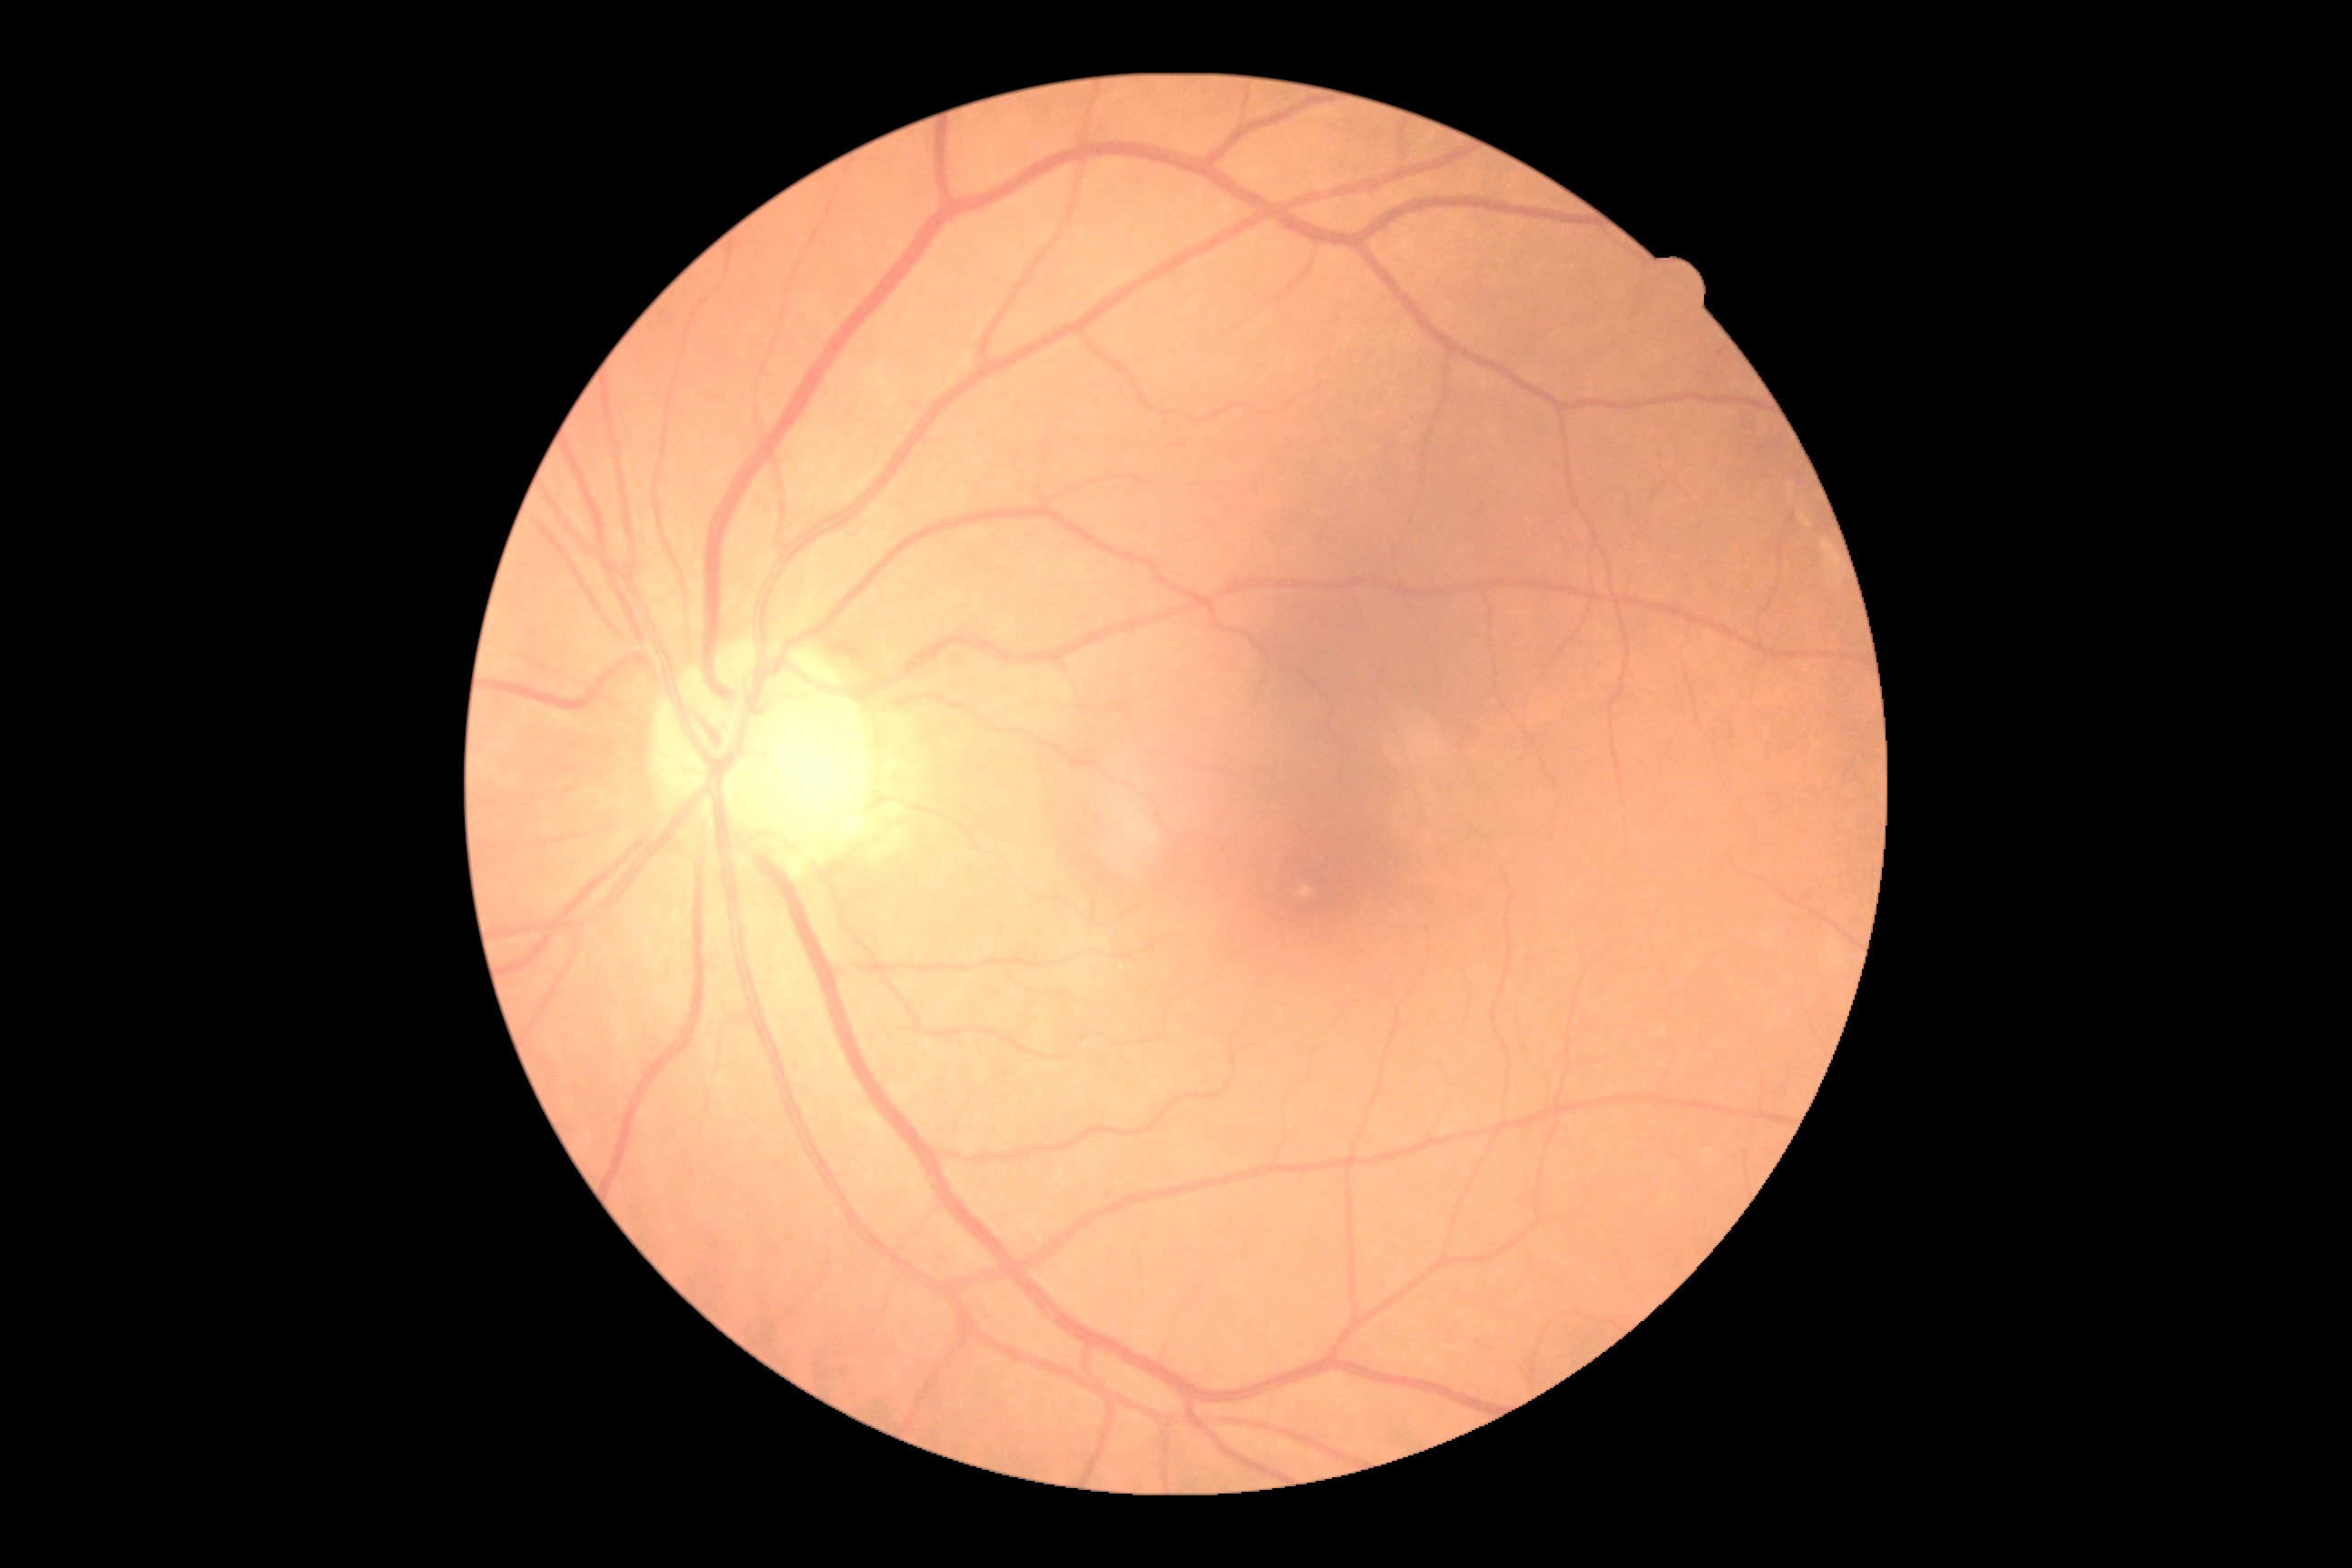

DR grade is 0 (no apparent retinopathy).
No DR findings.